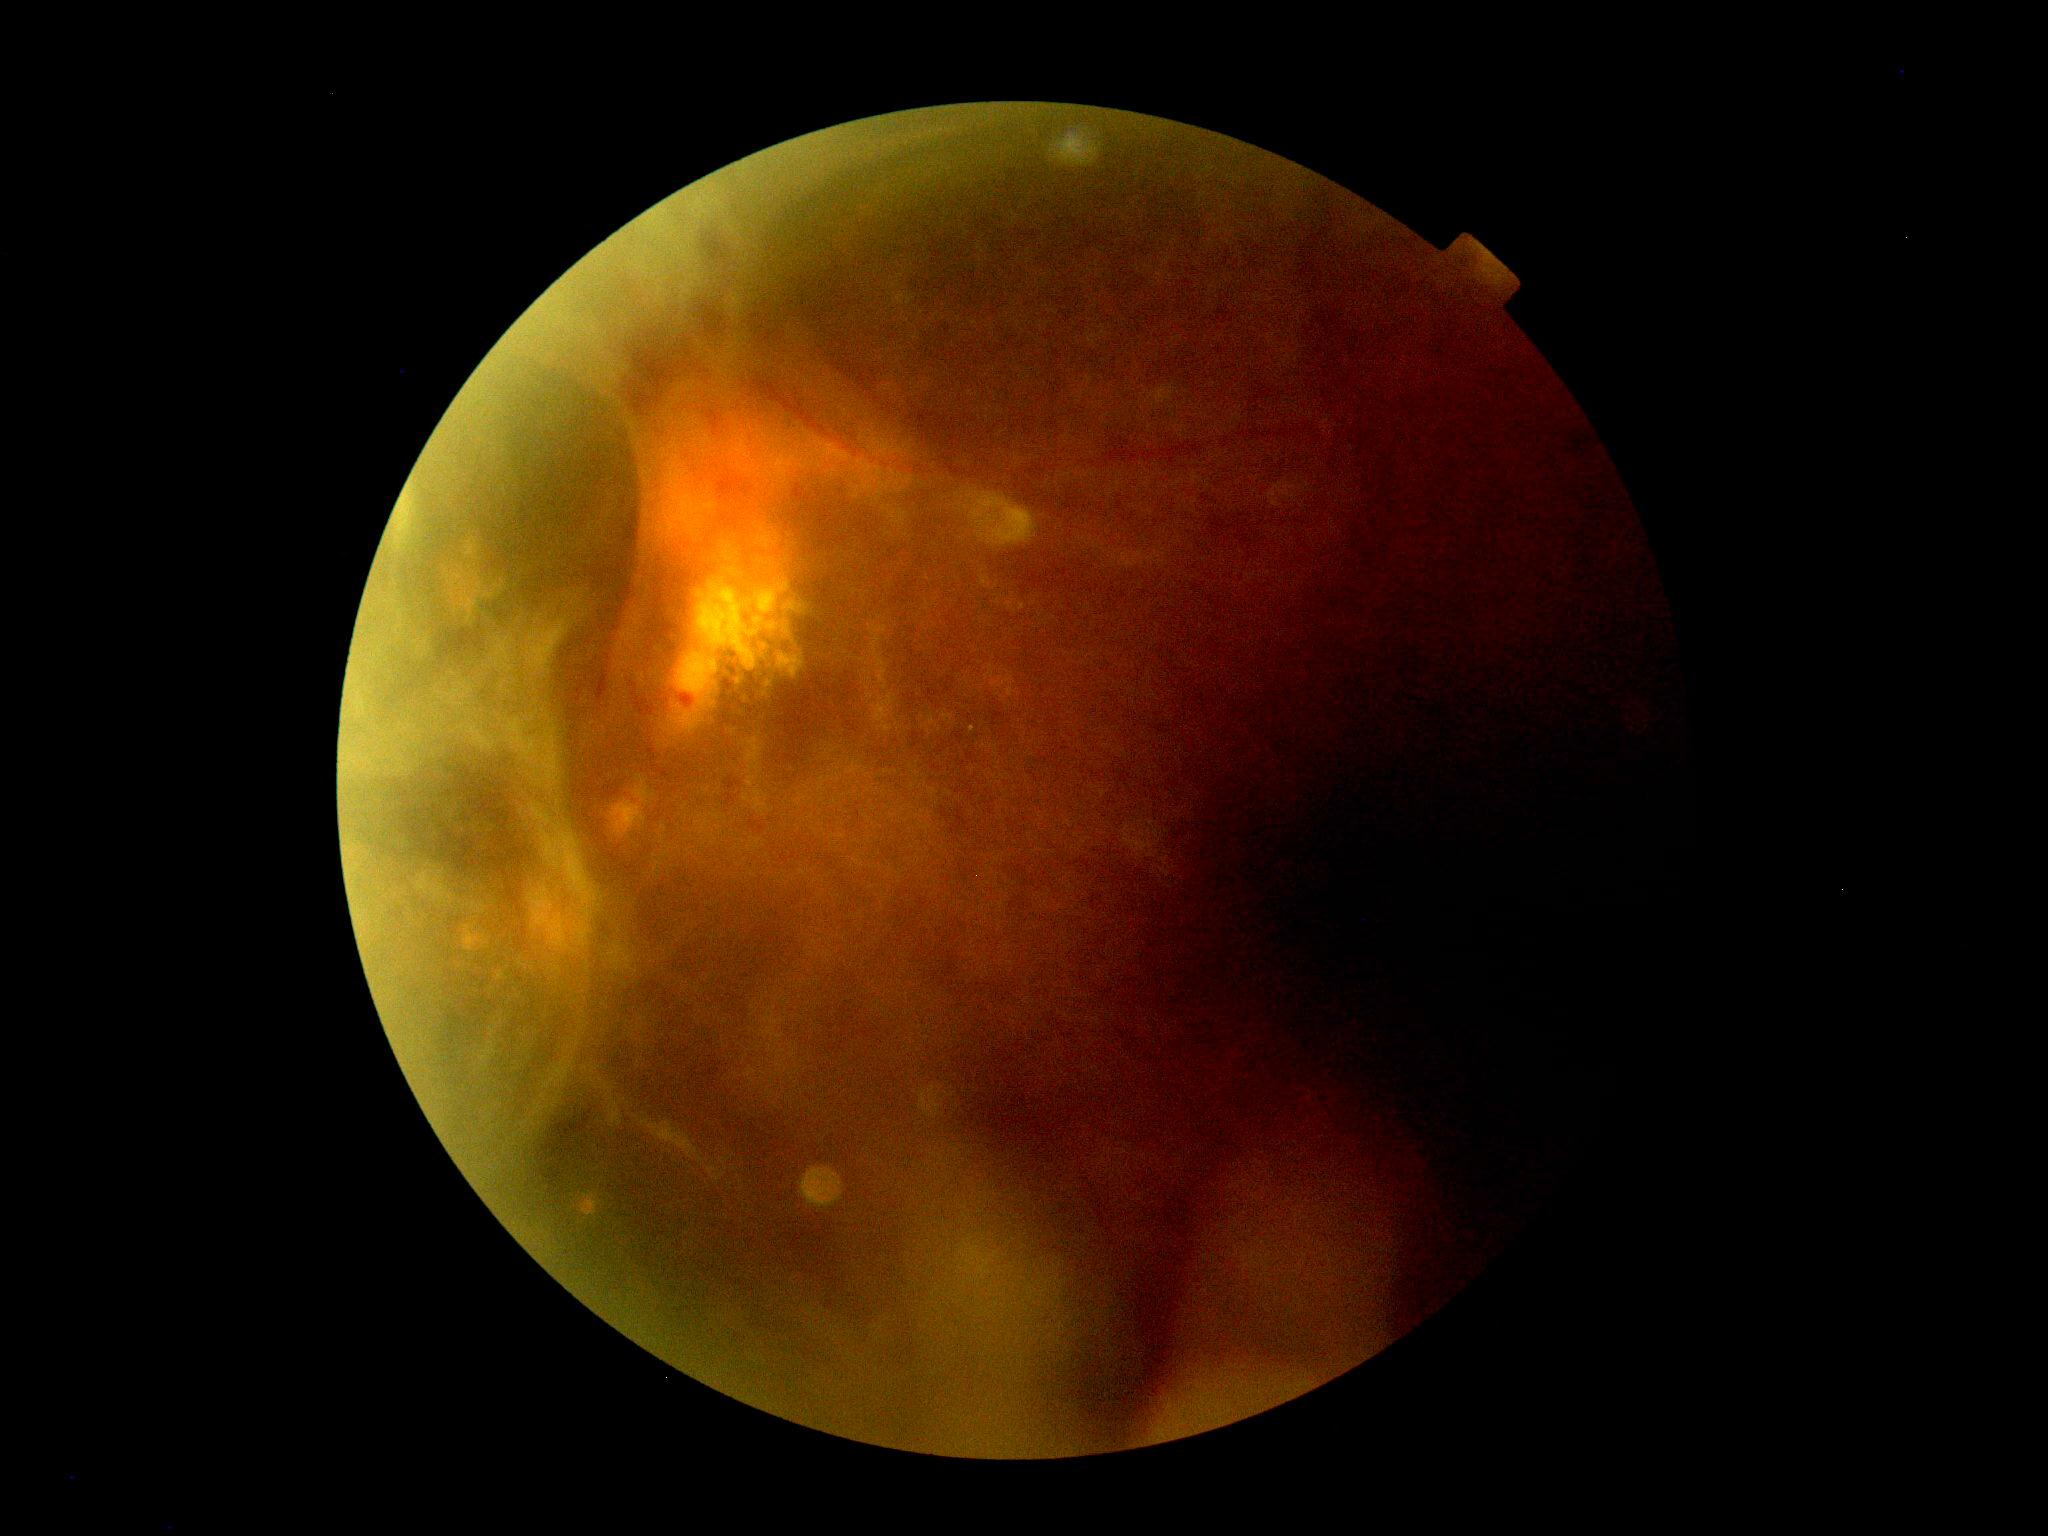 DR class: proliferative diabetic retinopathy. Diabetic retinopathy (DR) is 4 — neovascularization and/or vitreous/pre-retinal hemorrhage.